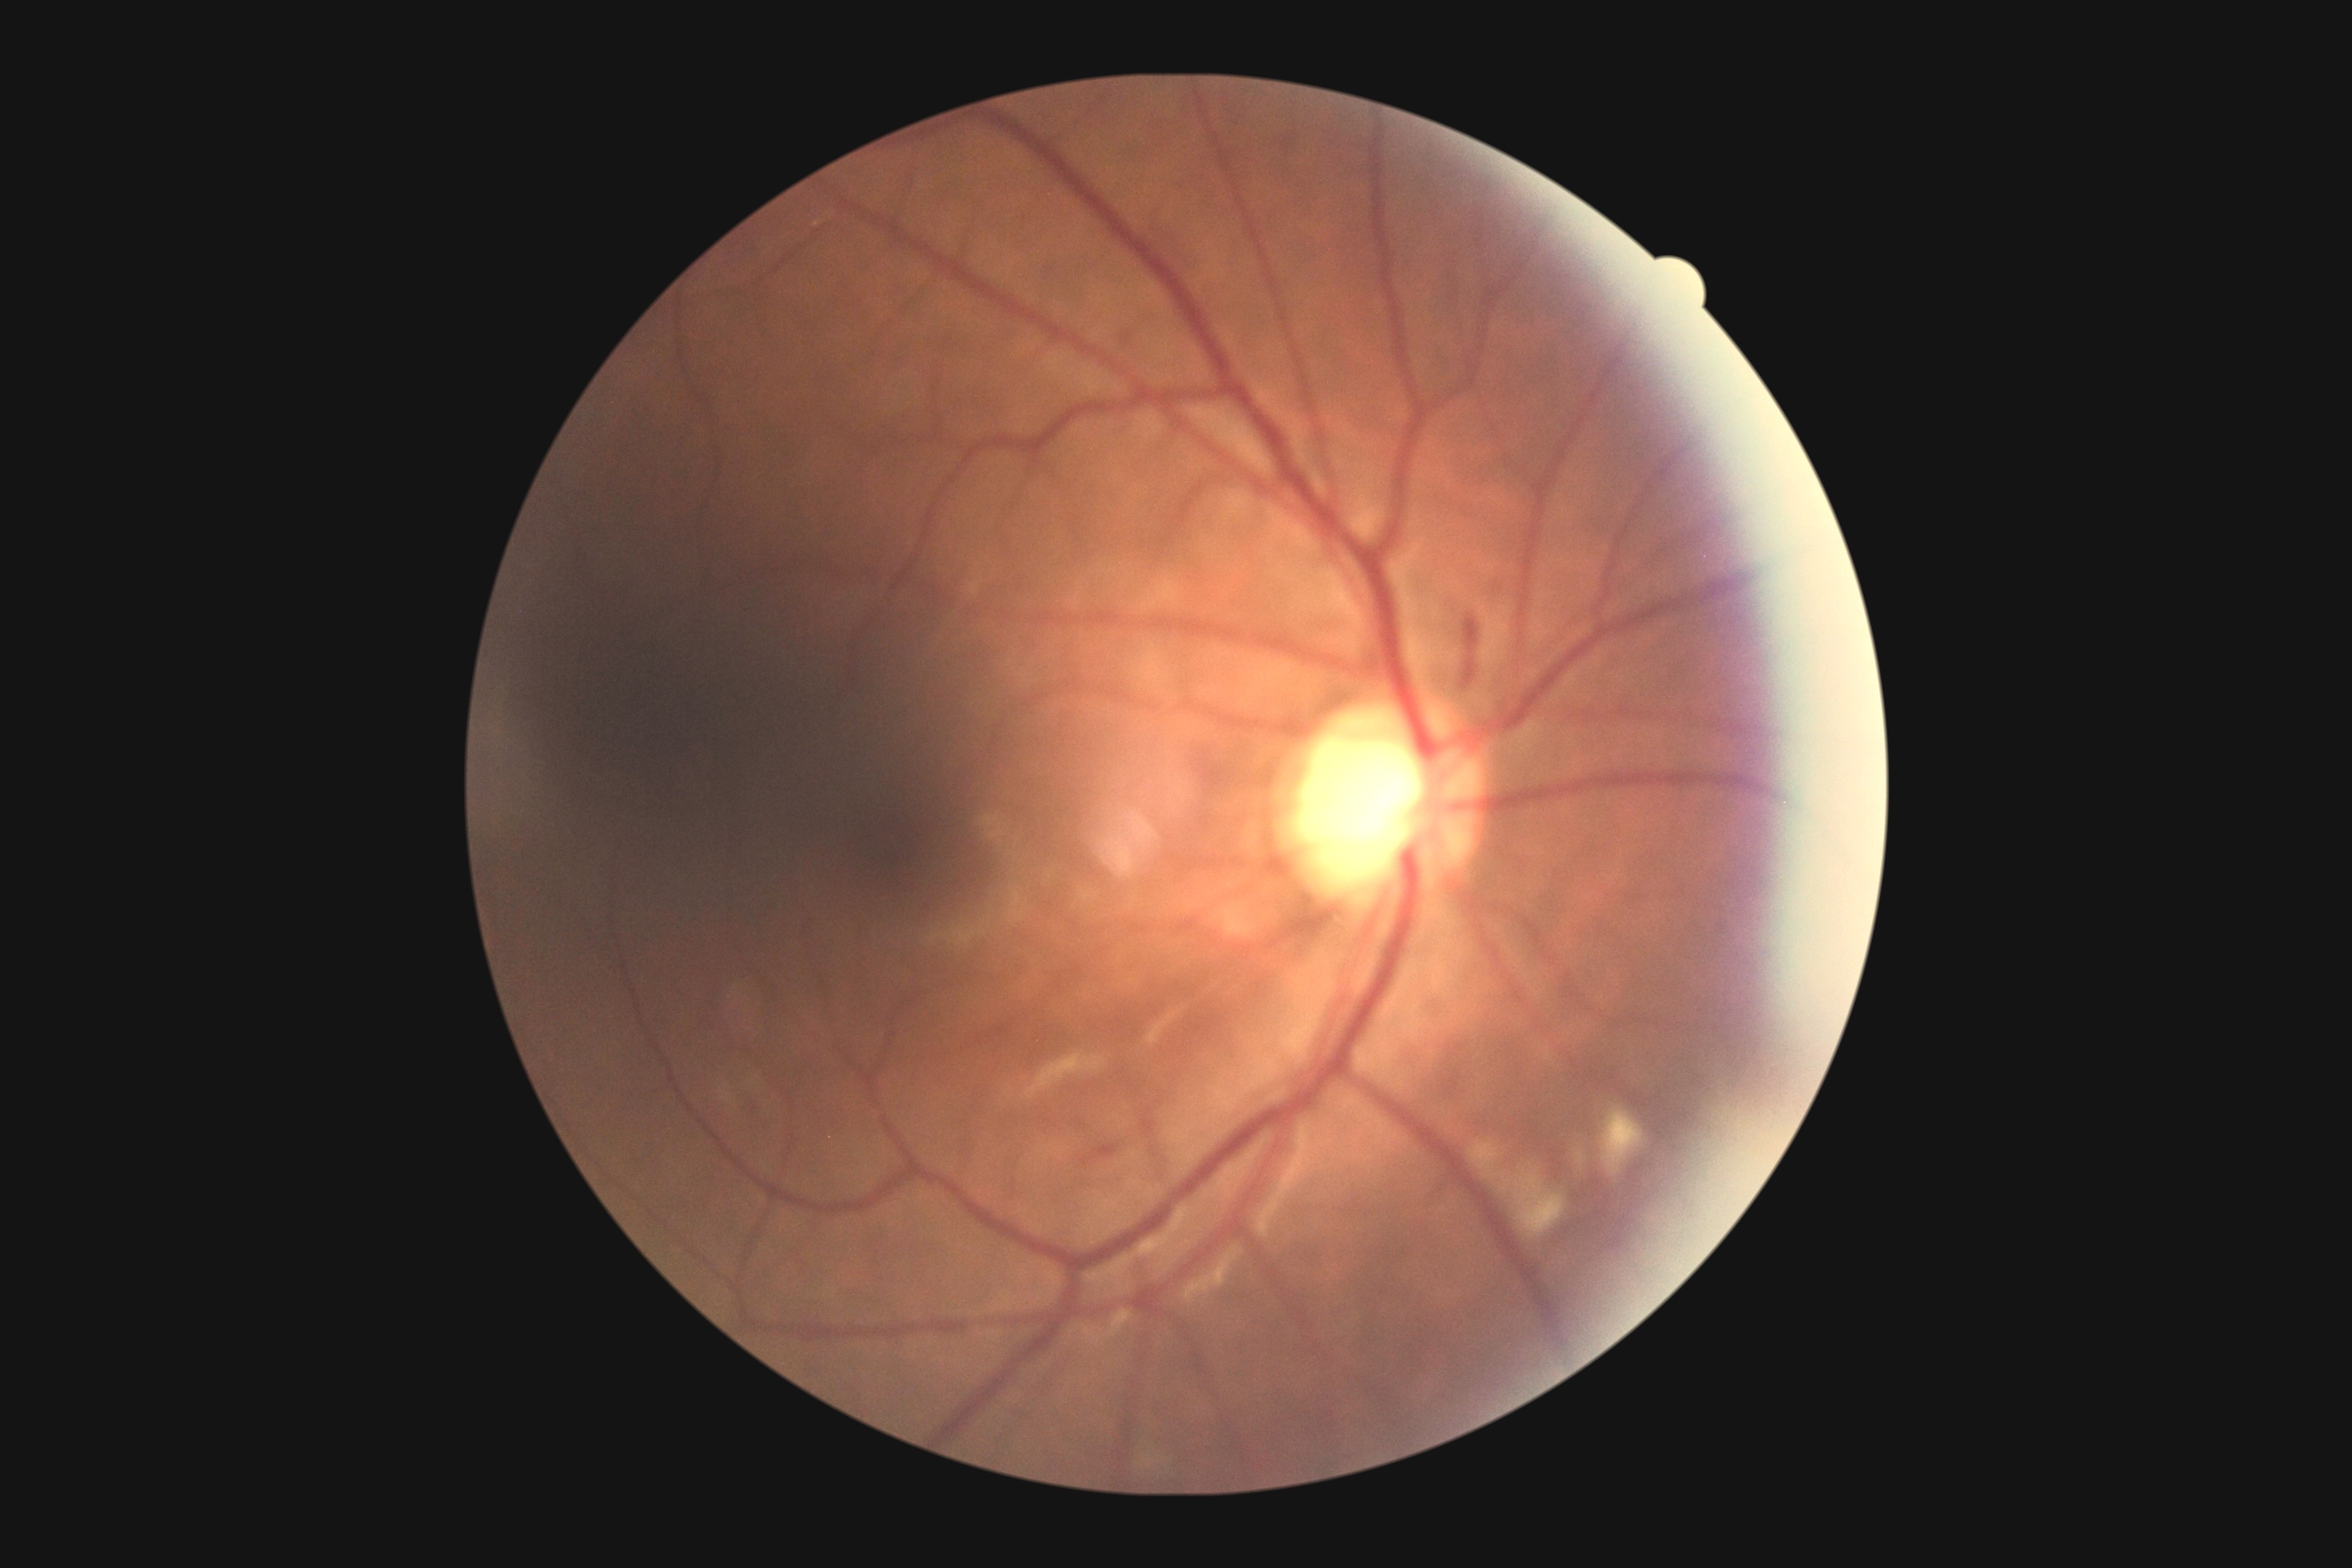

Diabetic retinopathy (DR): 2/4 — more than just microaneurysms but less than severe NPDR.